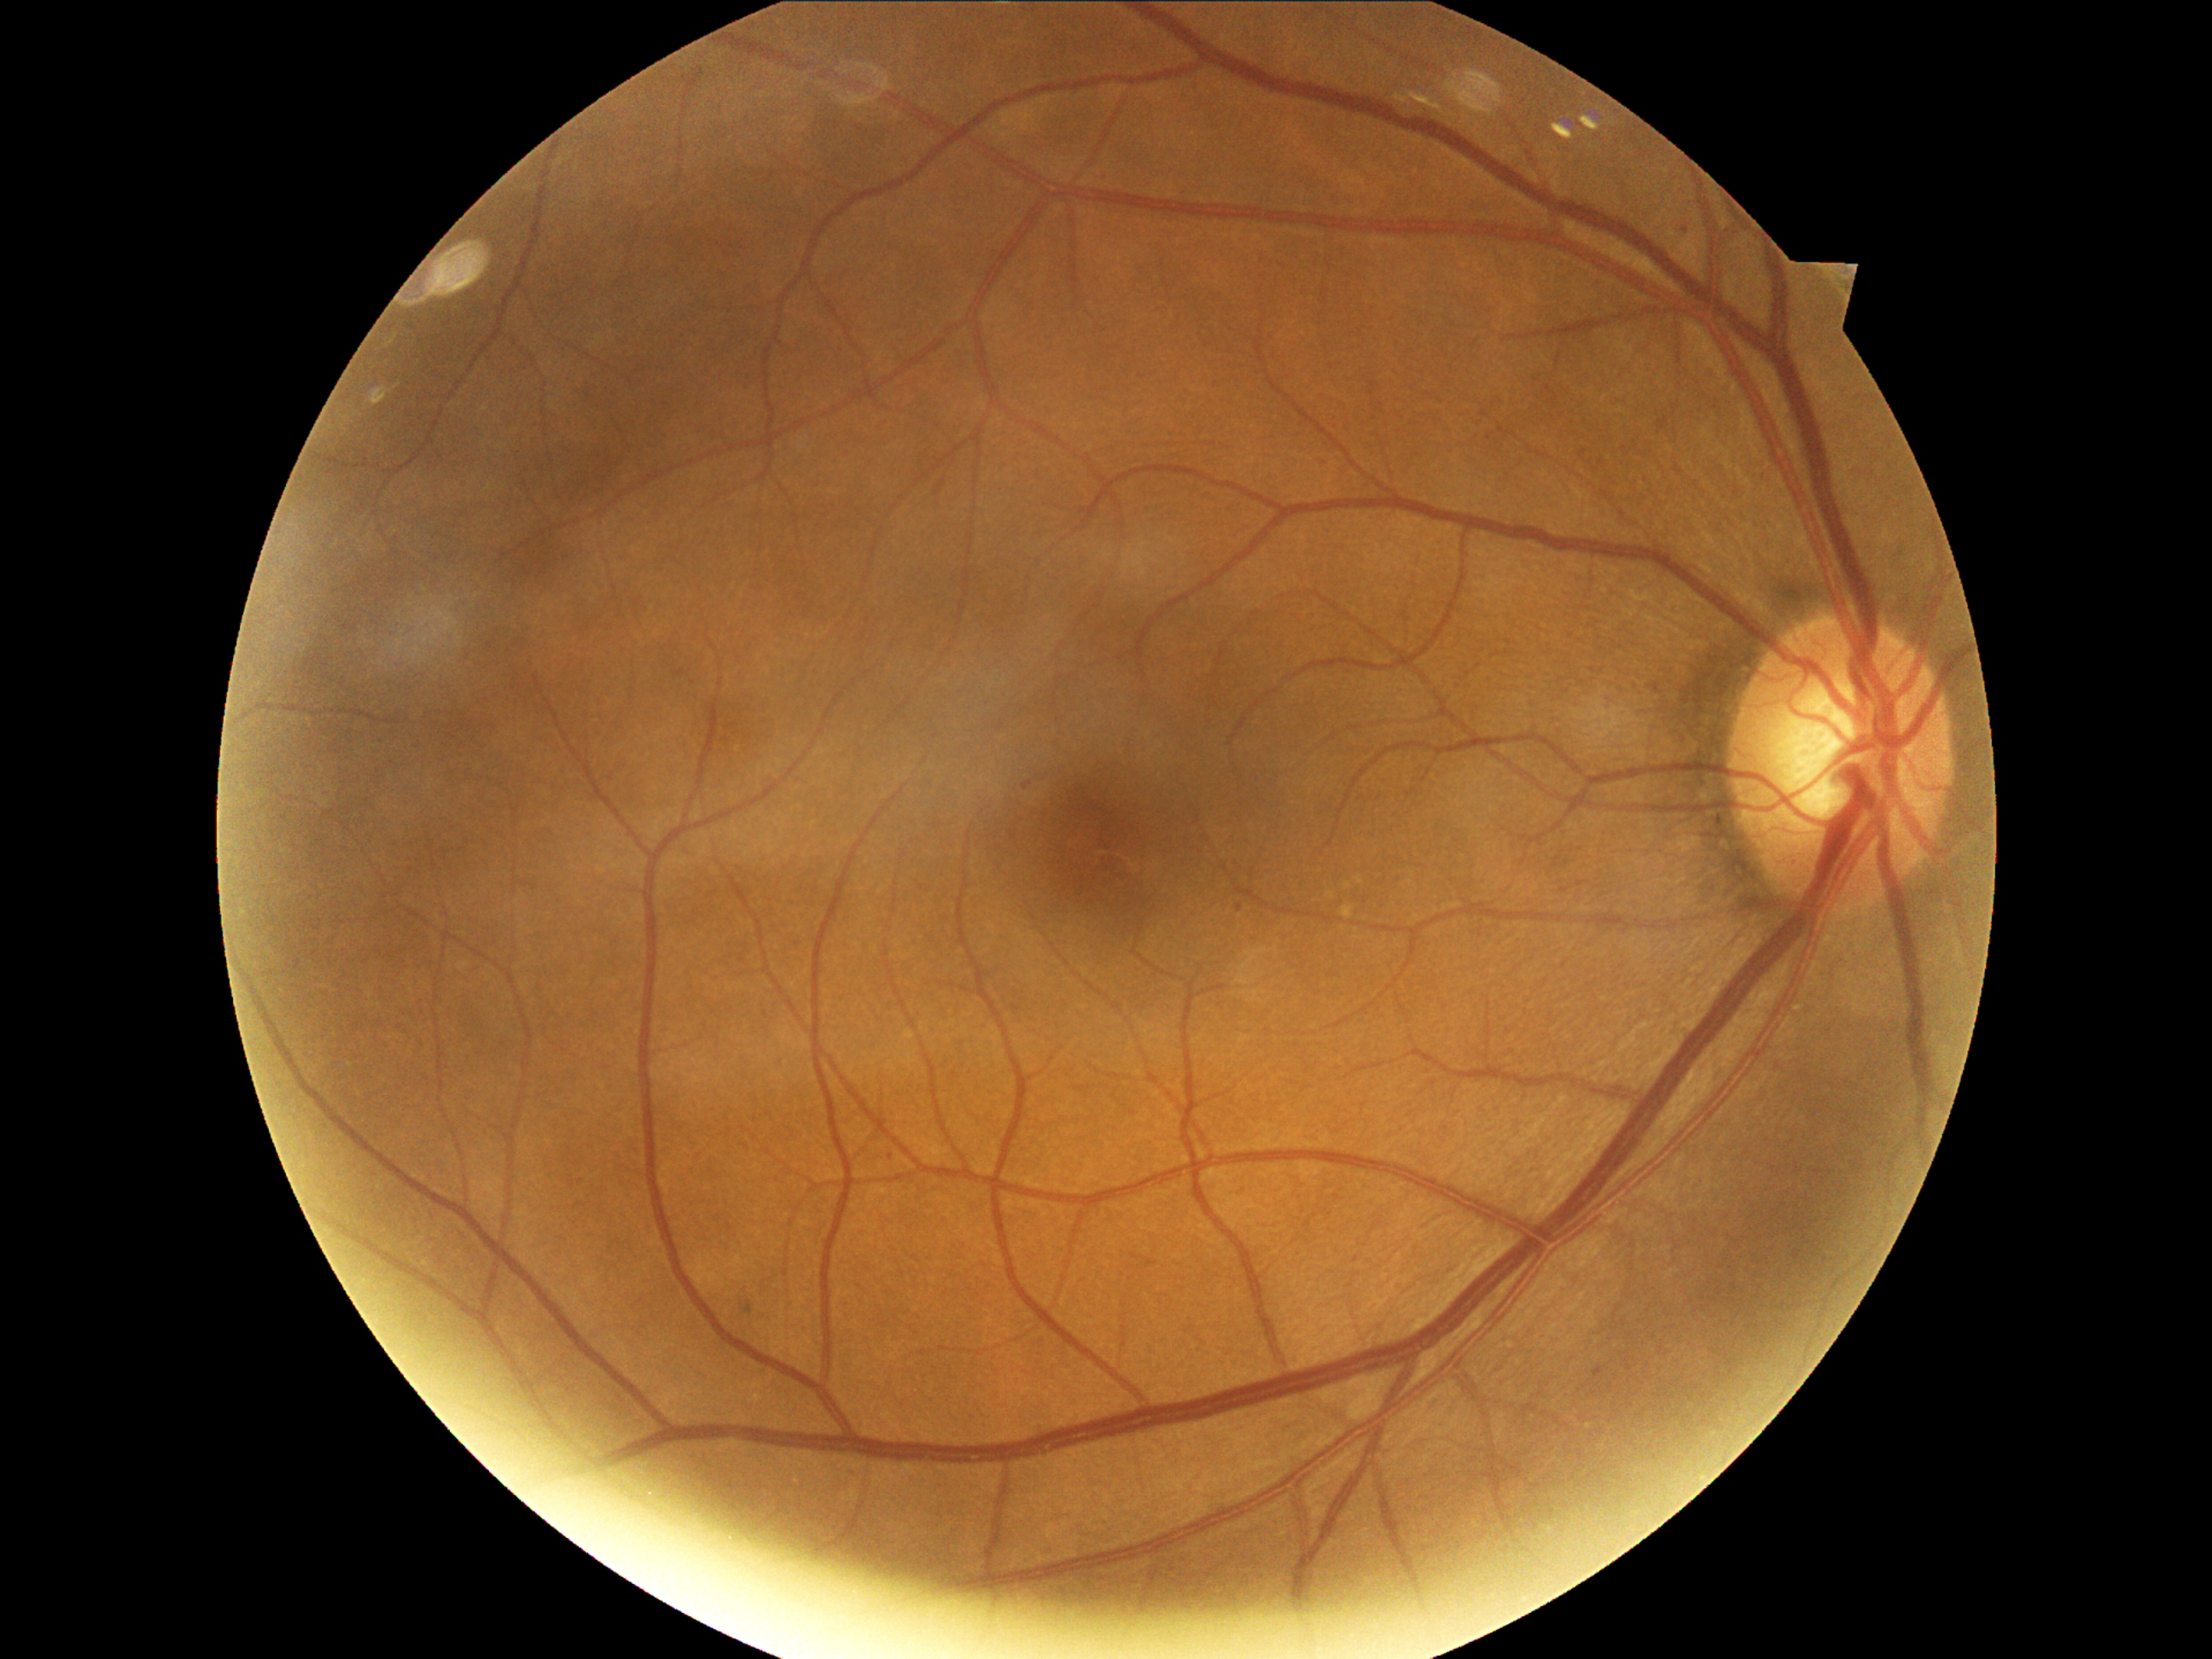
Annotations:
* DR severity — 1/4 — presence of microaneurysms only
* DR class — non-proliferative diabetic retinopathy